Retinal fundus photograph:
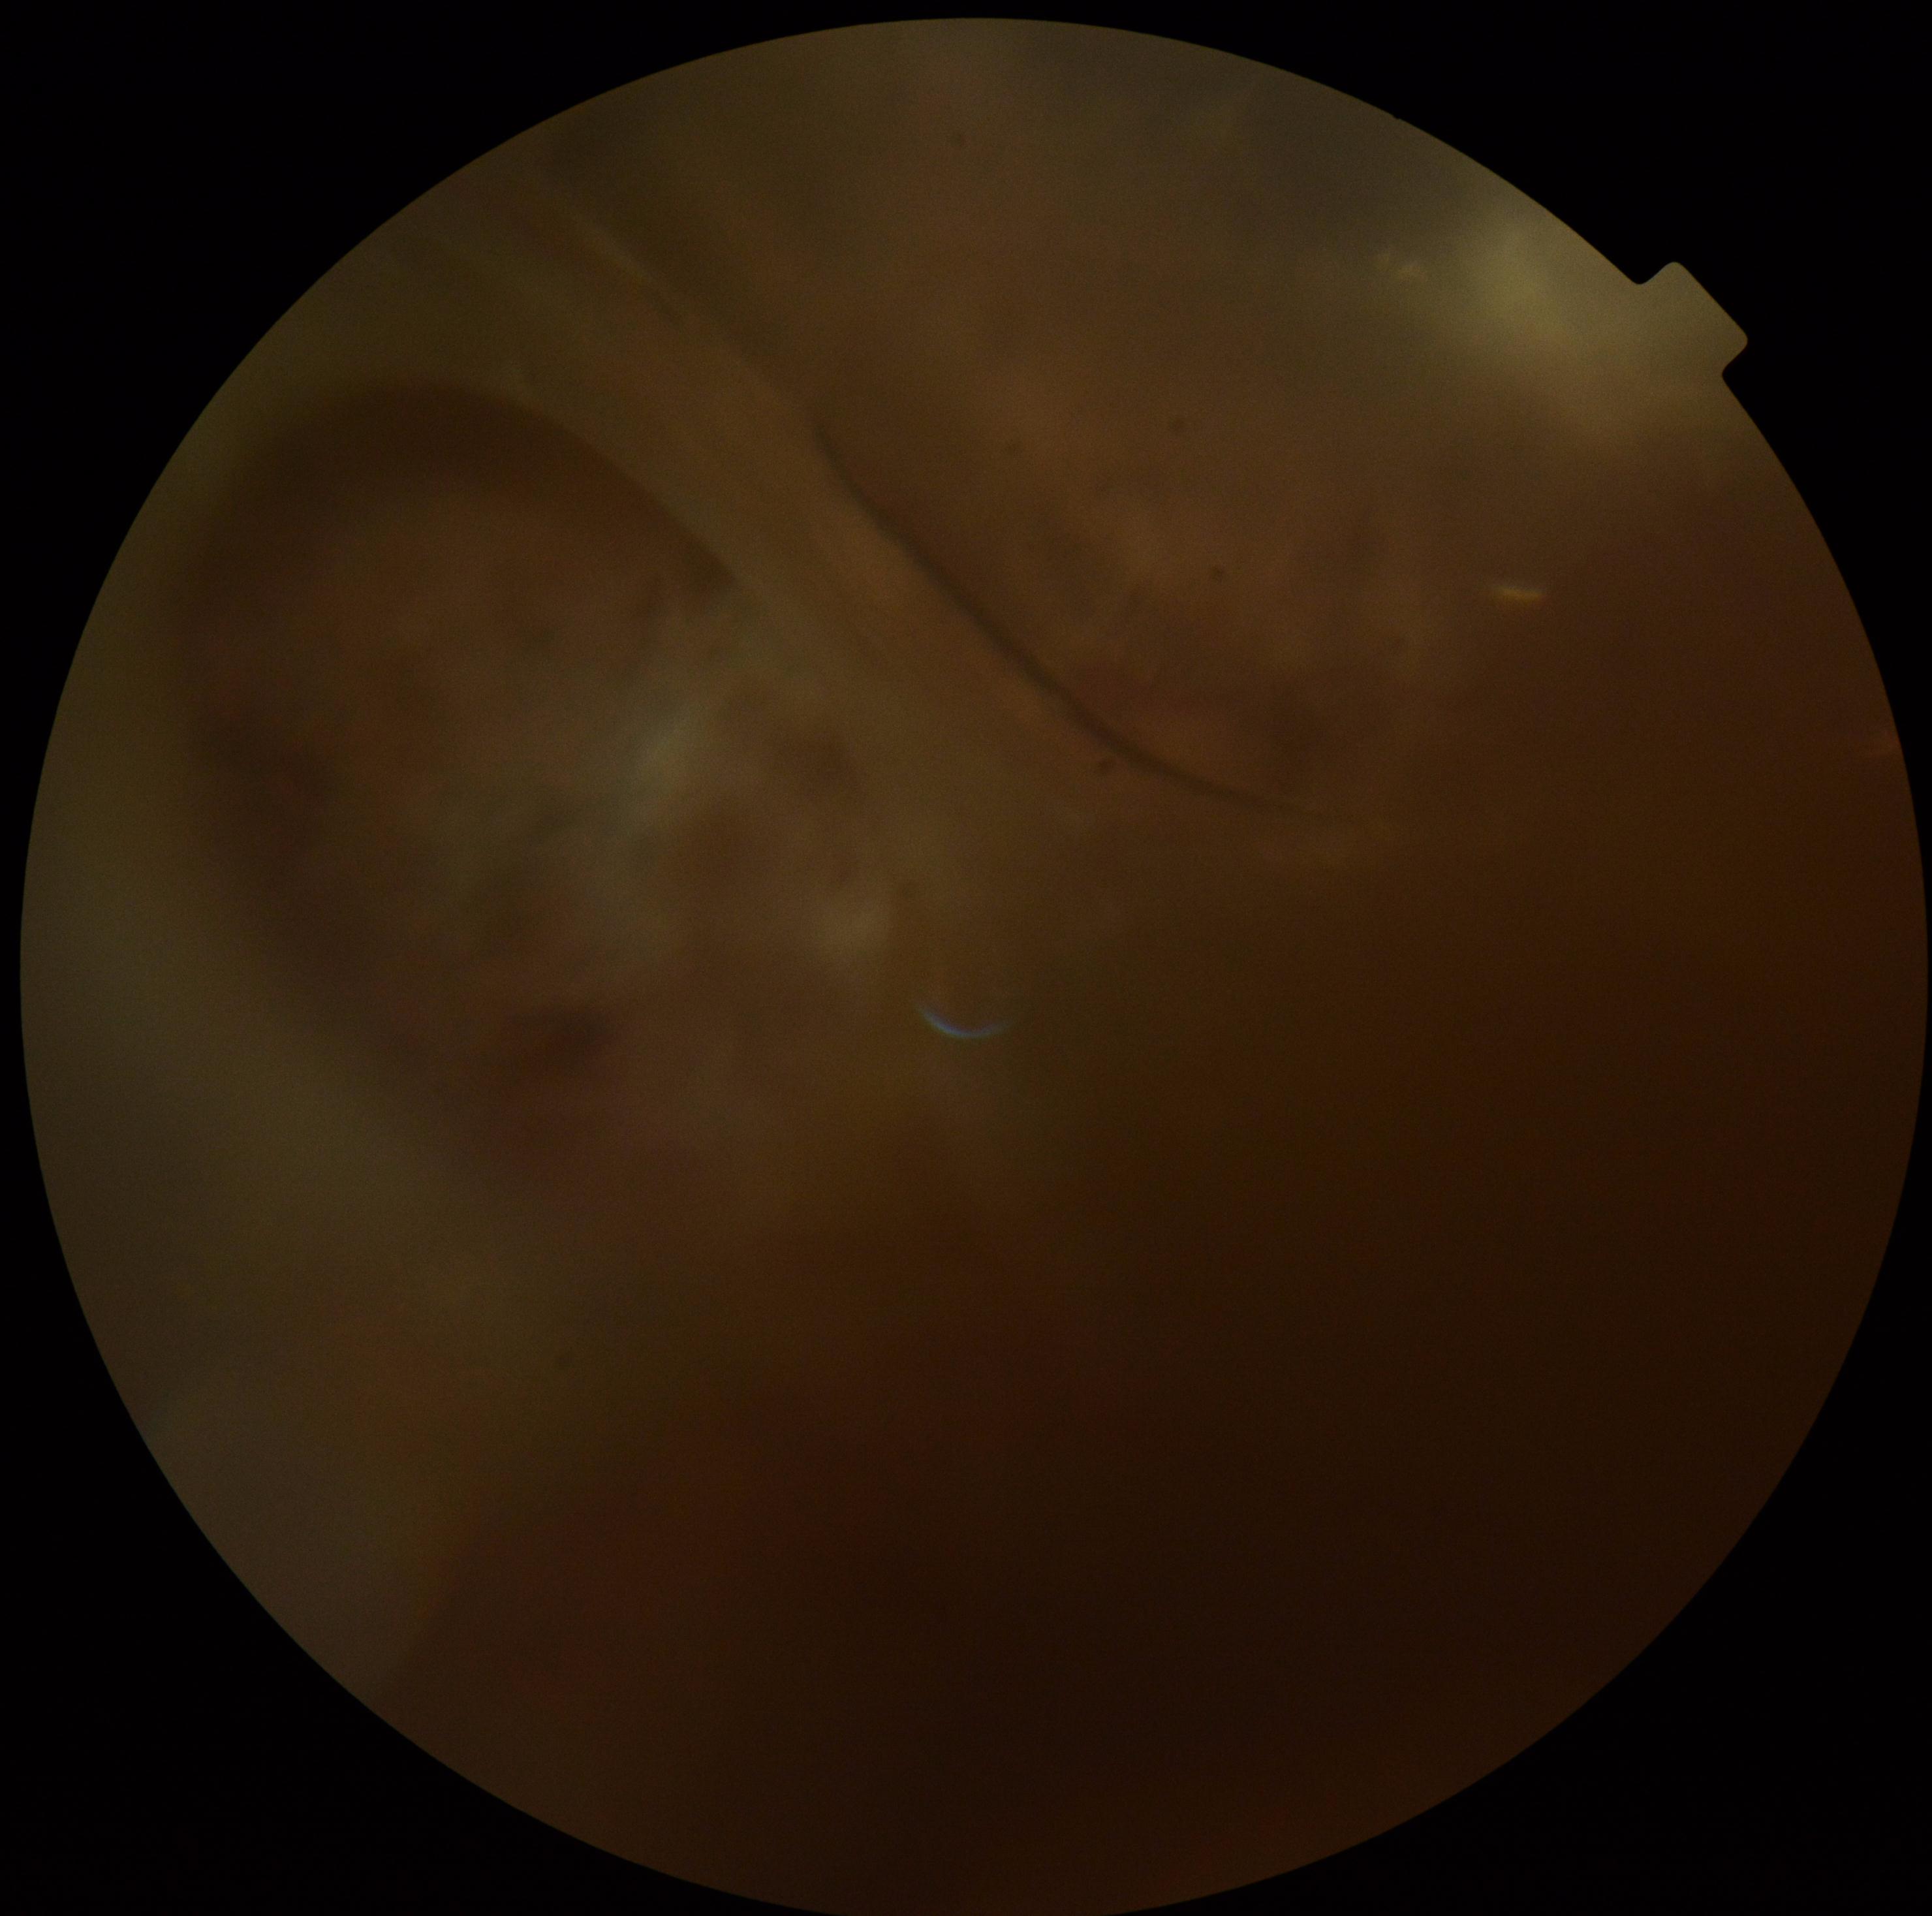
diabetic retinopathy (DR) = ungradable due to poor image quality | image quality = too poor for DR grading.